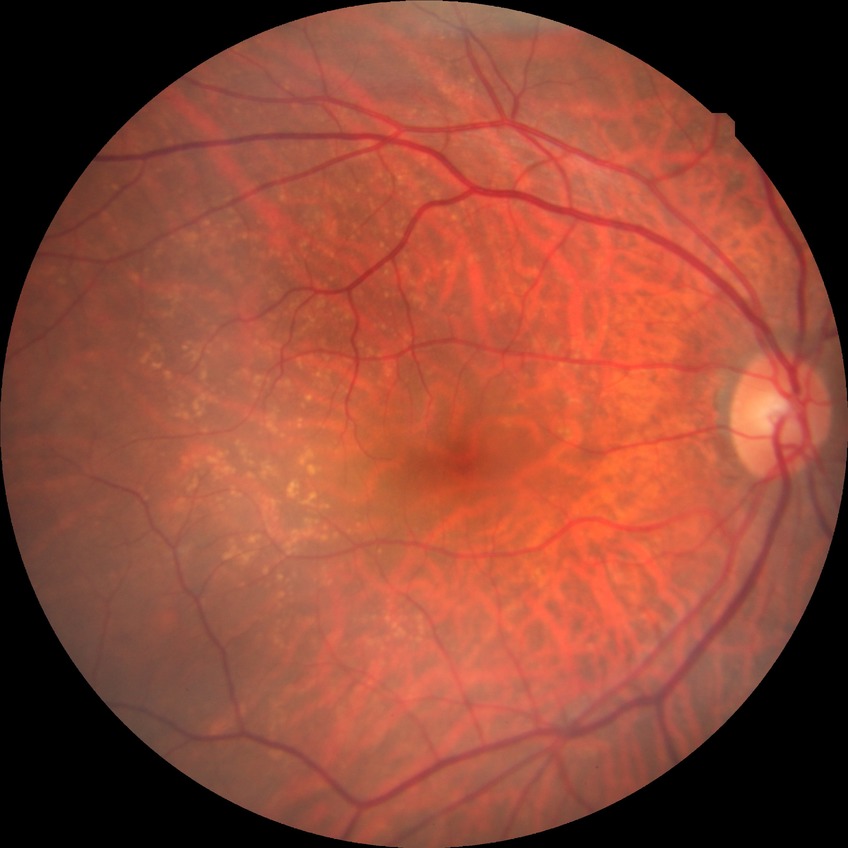 Retinopathy grade: no diabetic retinopathy.